512 by 512 pixels, color fundus photograph: 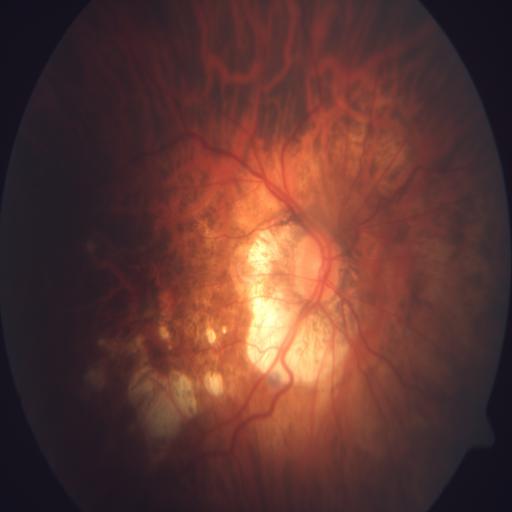

Findings consistent with myopia (MYA).